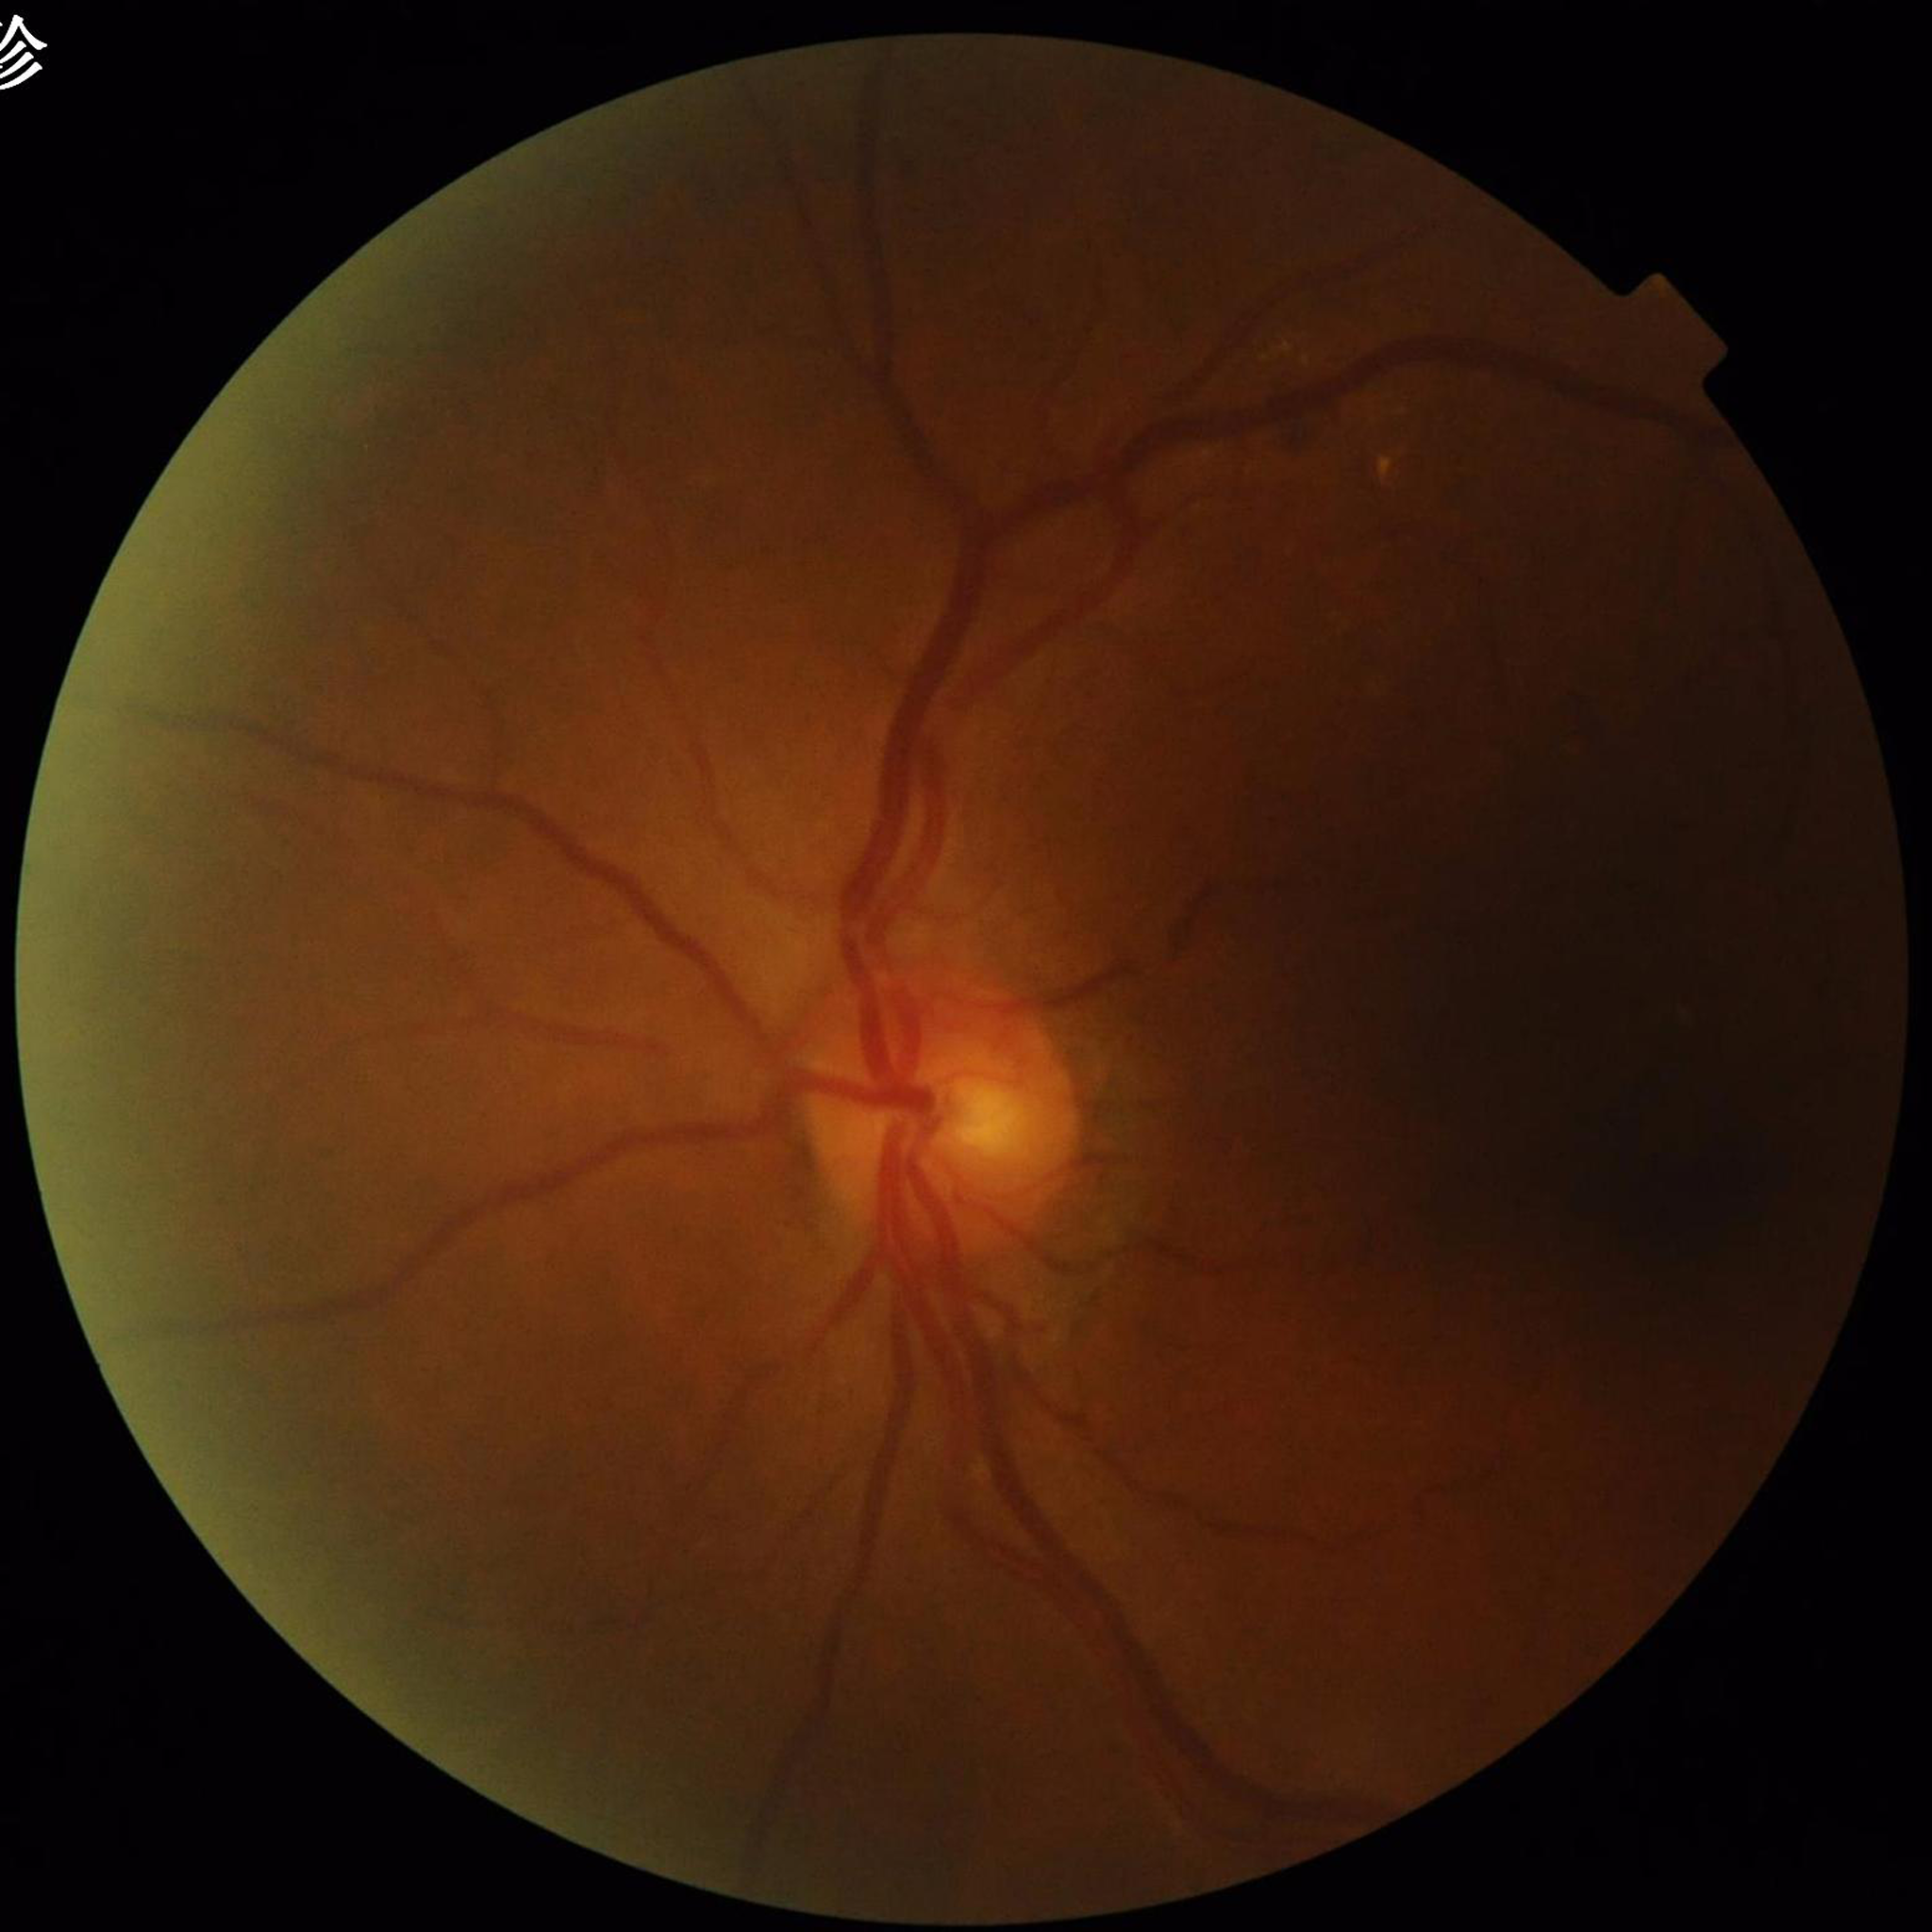

Diagnosed with diabetic retinopathy (DR).